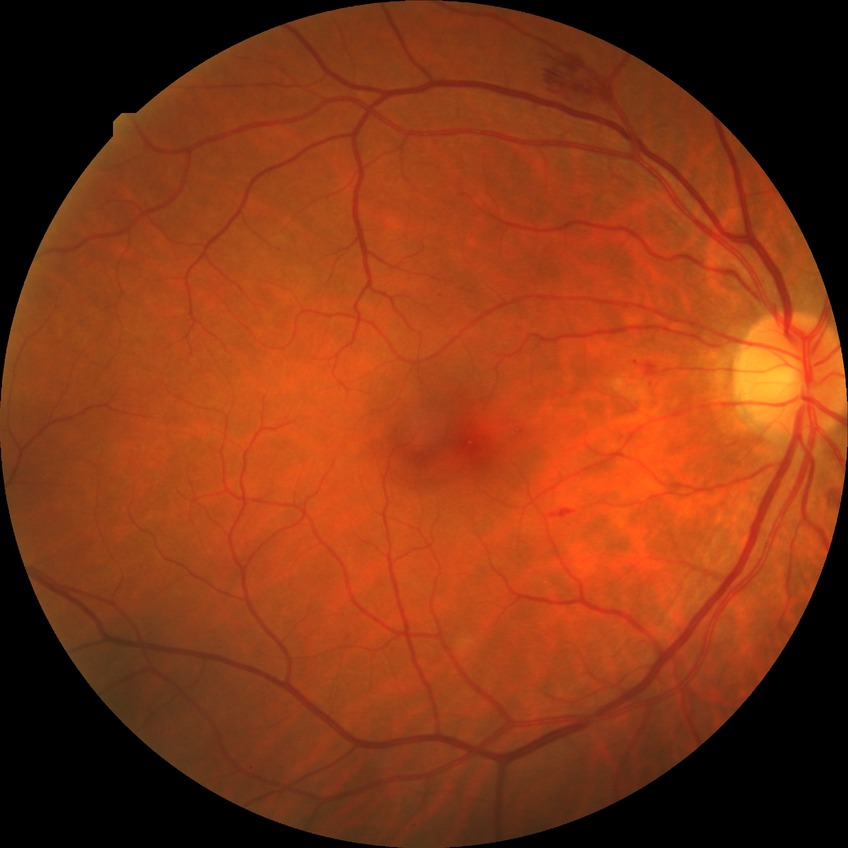
Modified Davis grading is simple diabetic retinopathy. Disease class: non-proliferative diabetic retinopathy.